130° field of view (Natus RetCam Envision) · wide-field fundus photograph of an infant · 1440x1080: 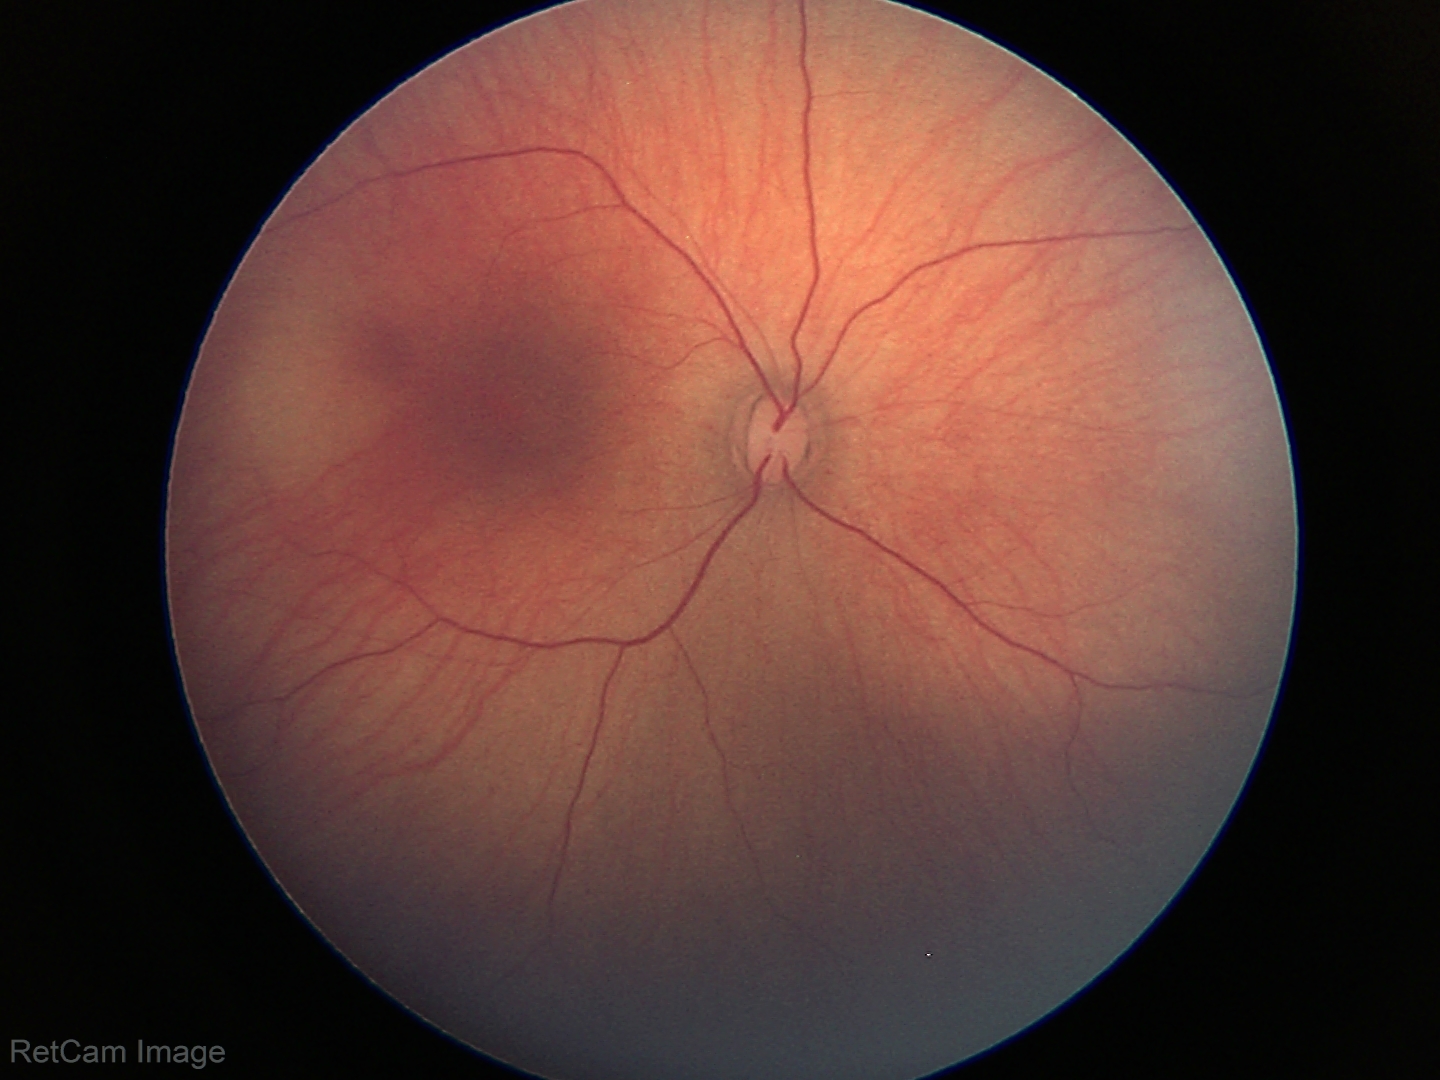

Q: What is the diagnosis from this examination?
A: physiological retinal finding